Color fundus photograph; 2352 x 1568 pixels: 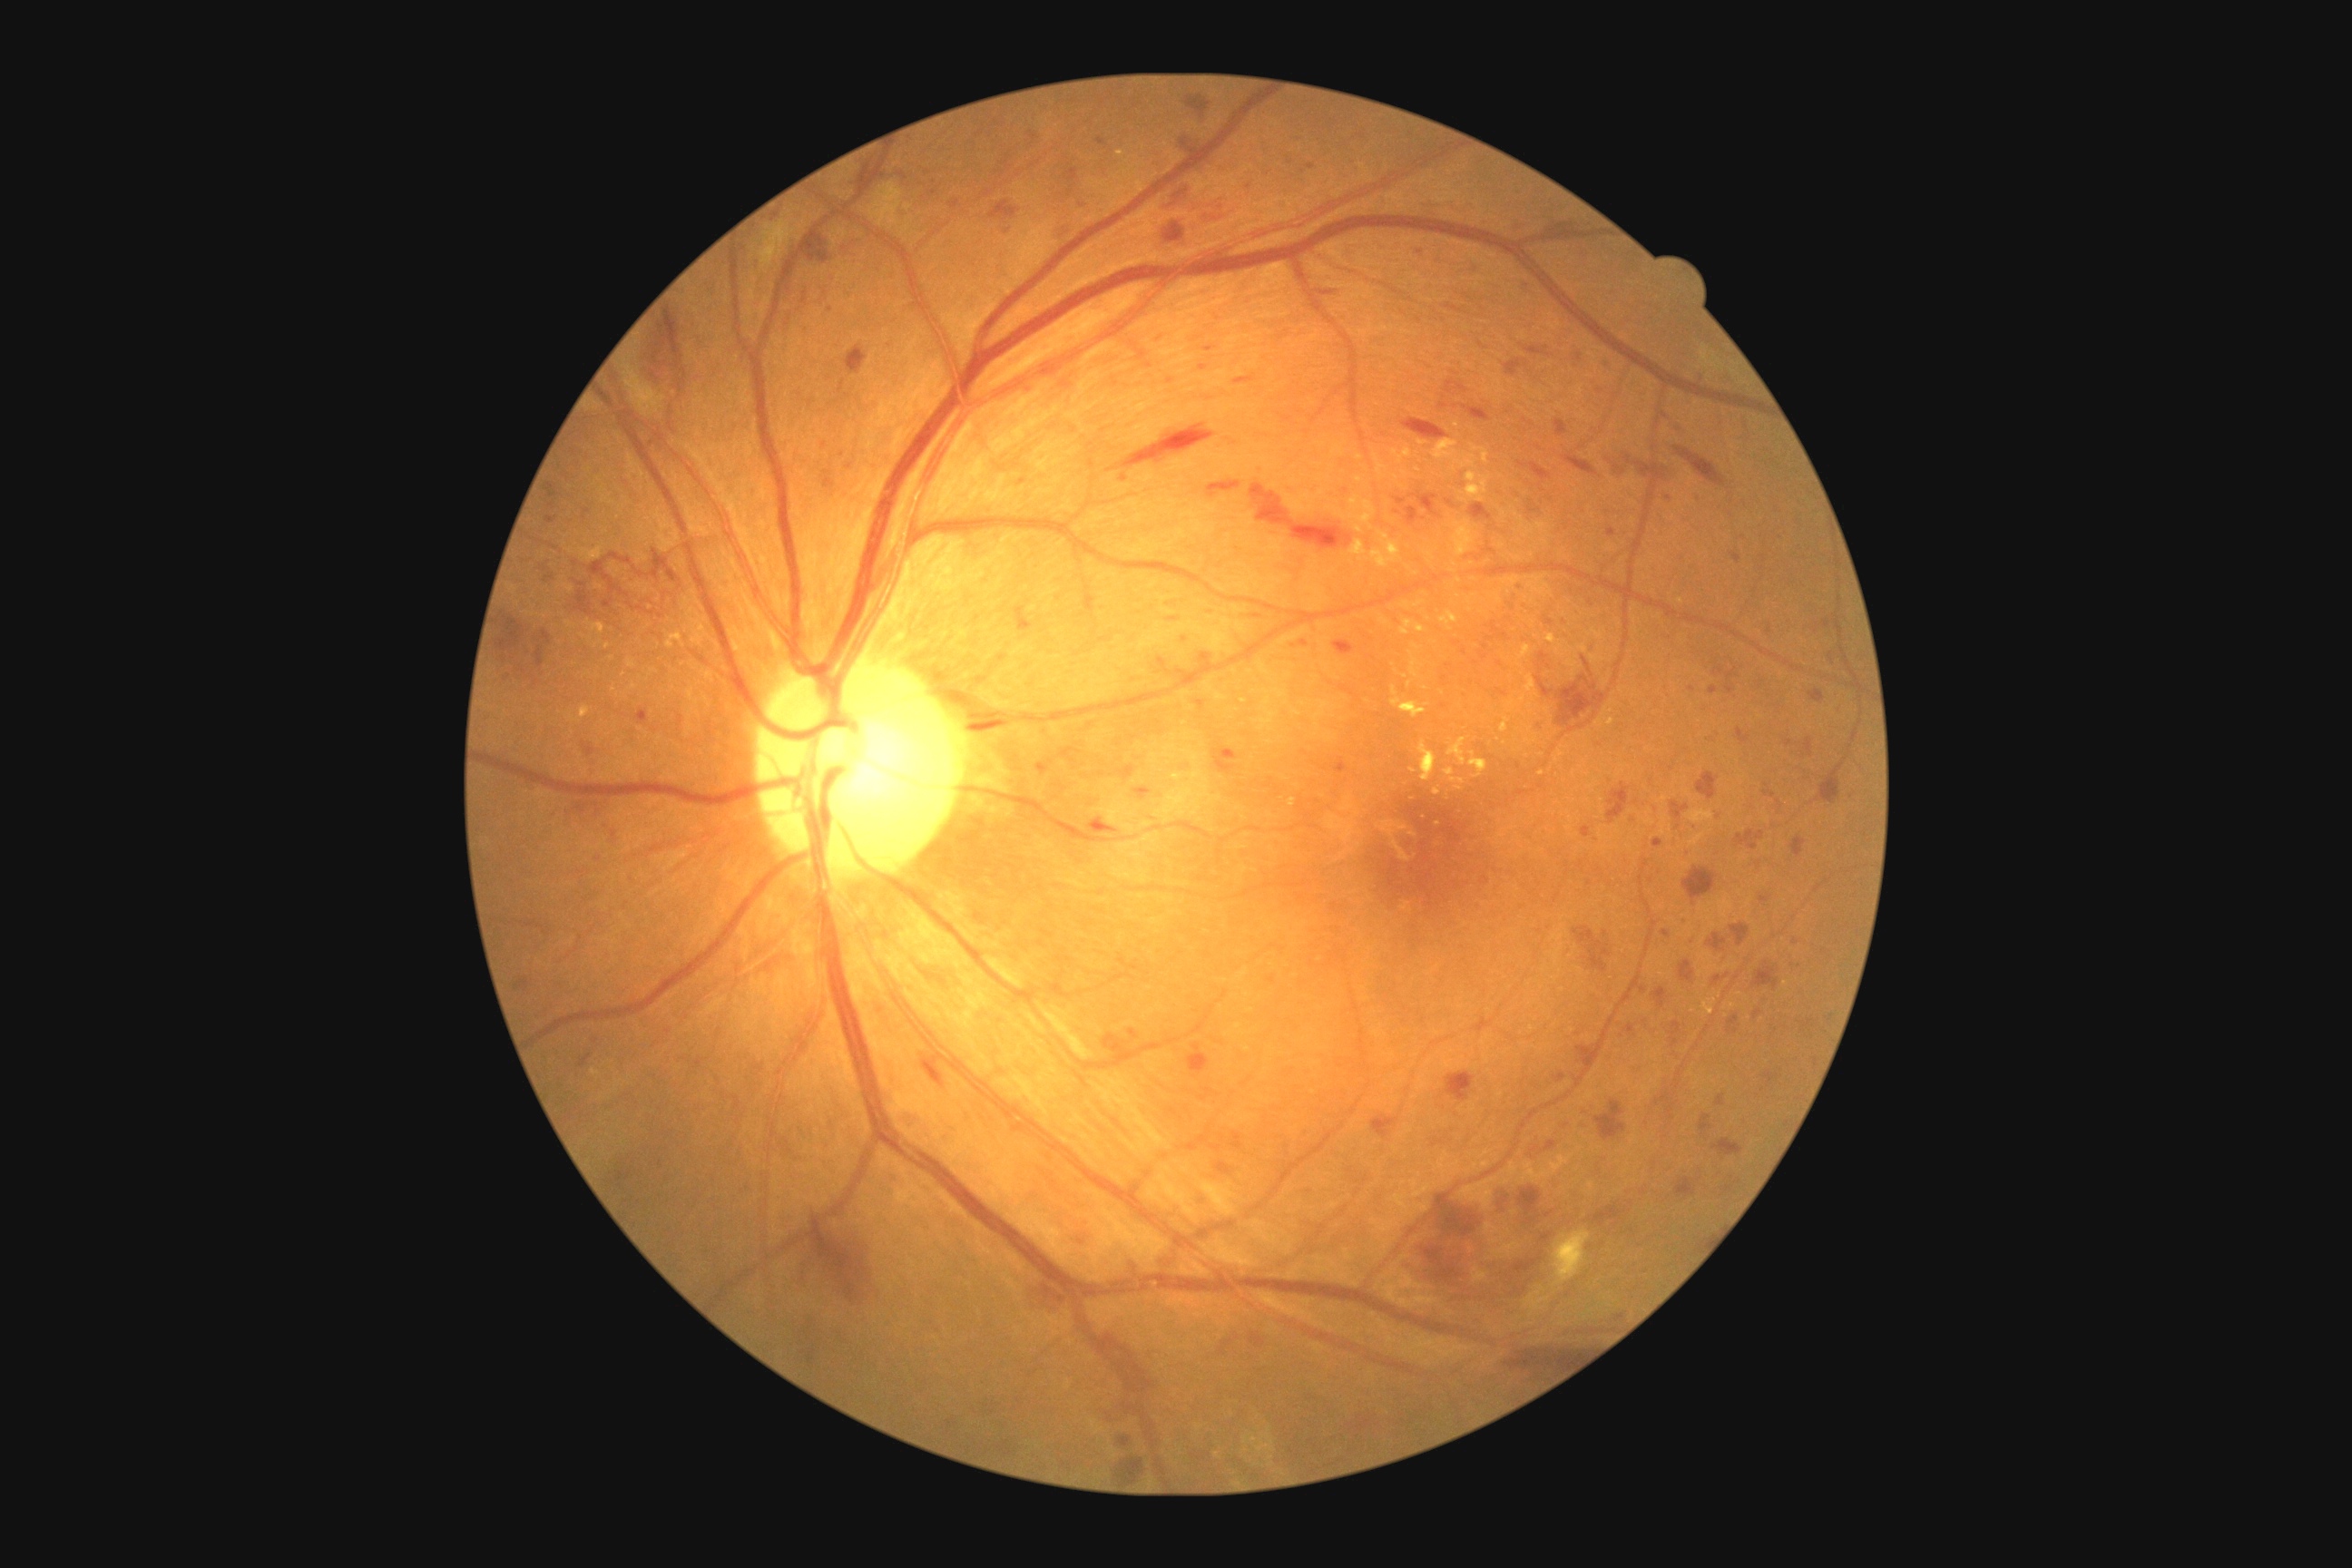 <lesions partial="true">
  <dr_grade>3</dr_grade>
  <he partial="true">box(1683, 868, 1716, 901) | box(1193, 1195, 1208, 1204) | box(1030, 132, 1039, 141) | box(549, 502, 554, 511) | box(1054, 222, 1070, 239) | box(1545, 1142, 1558, 1152) | box(1738, 729, 1750, 745) | box(1106, 1335, 1153, 1391) | box(1088, 819, 1117, 834) | box(651, 551, 678, 582) | box(1660, 413, 1669, 420) | box(1525, 346, 1551, 358) | box(1698, 772, 1721, 801) | box(1518, 1188, 1542, 1215) | box(966, 723, 1004, 732) | box(582, 741, 596, 758) | box(1672, 424, 1689, 435) | box(678, 369, 687, 393) | box(1014, 607, 1034, 632)</he>
  <he_small_approx>1566, 635</he_small_approx>
</lesions>